Graded on the modified Davis scale. Acquired with a NIDEK AFC-230
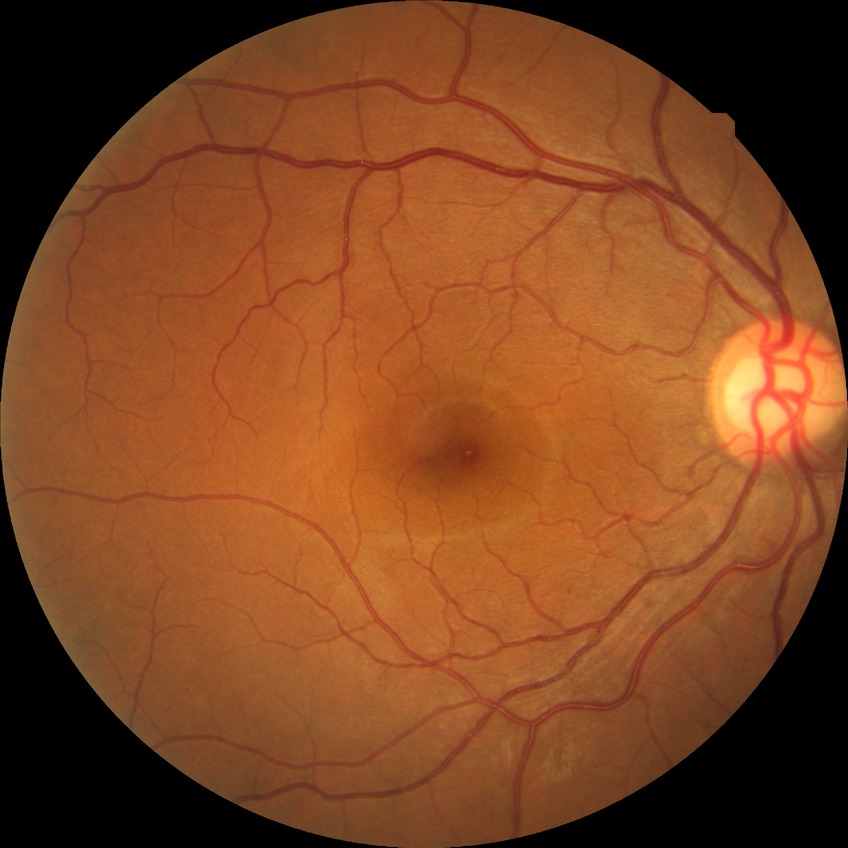

Diabetic retinopathy (DR): no diabetic retinopathy (NDR).